848 x 848 pixels
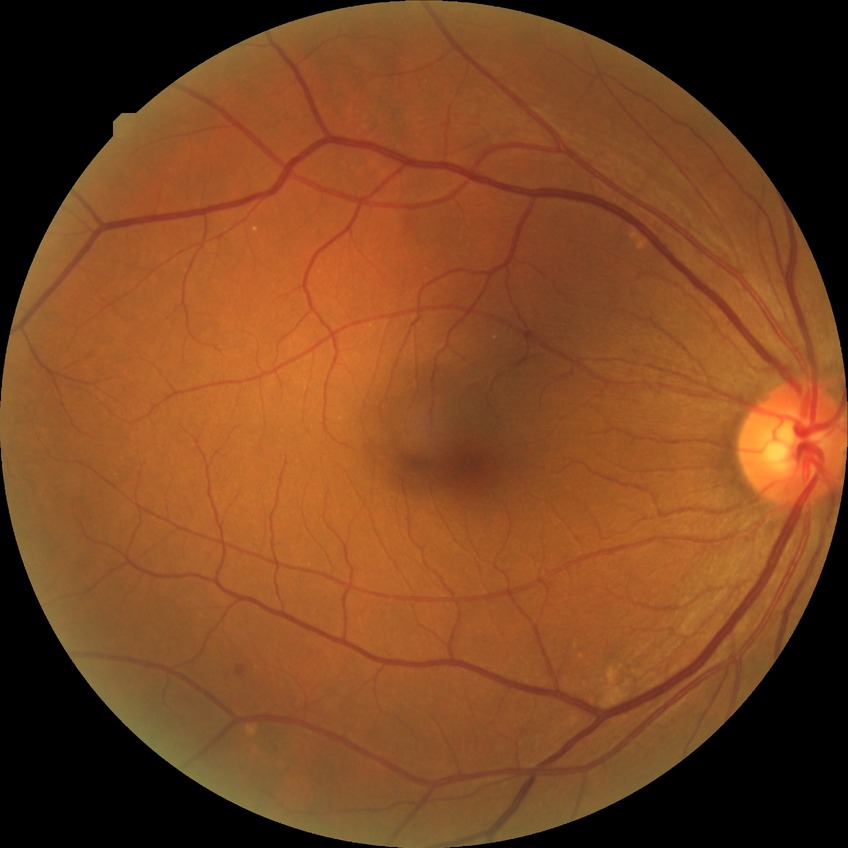
• diabetic retinopathy (DR): NDR (no diabetic retinopathy)